2352 x 1568 pixels; CFP; 45° FOV:
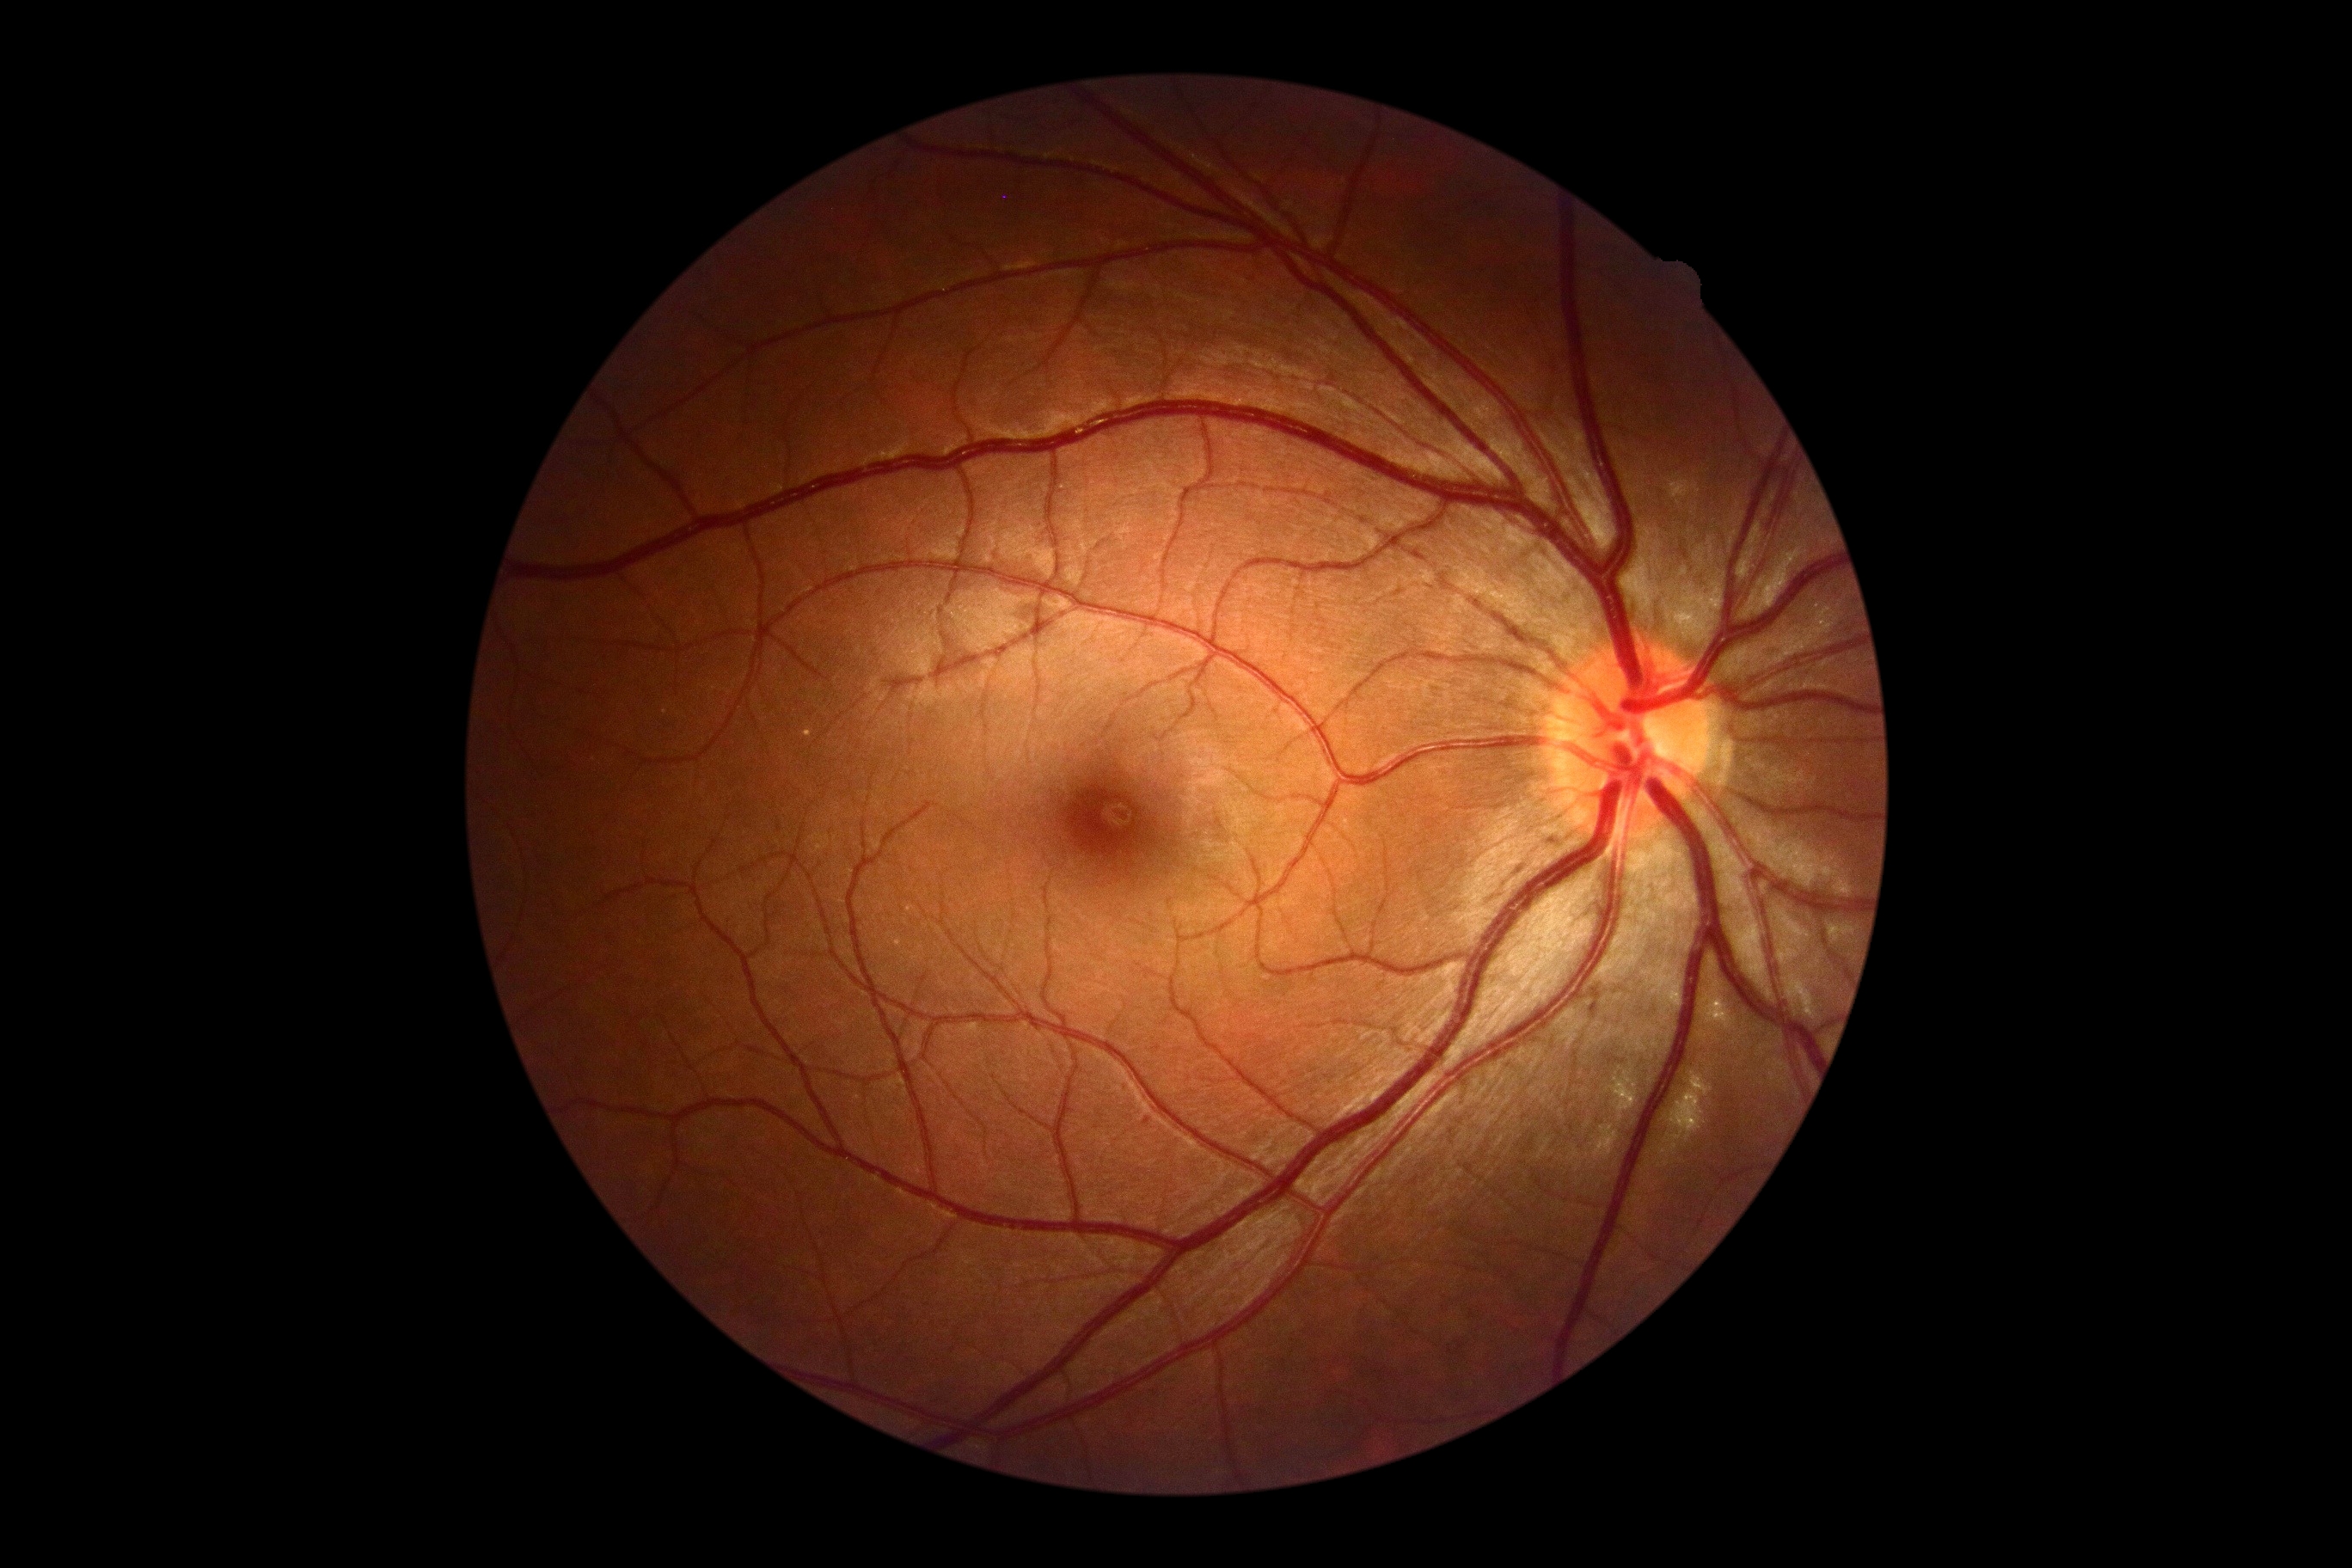

diabetic retinopathy grade = 0/4 — no visible signs of diabetic retinopathy.